Optic disc at the center of the field · non-mydriatic acquisition:
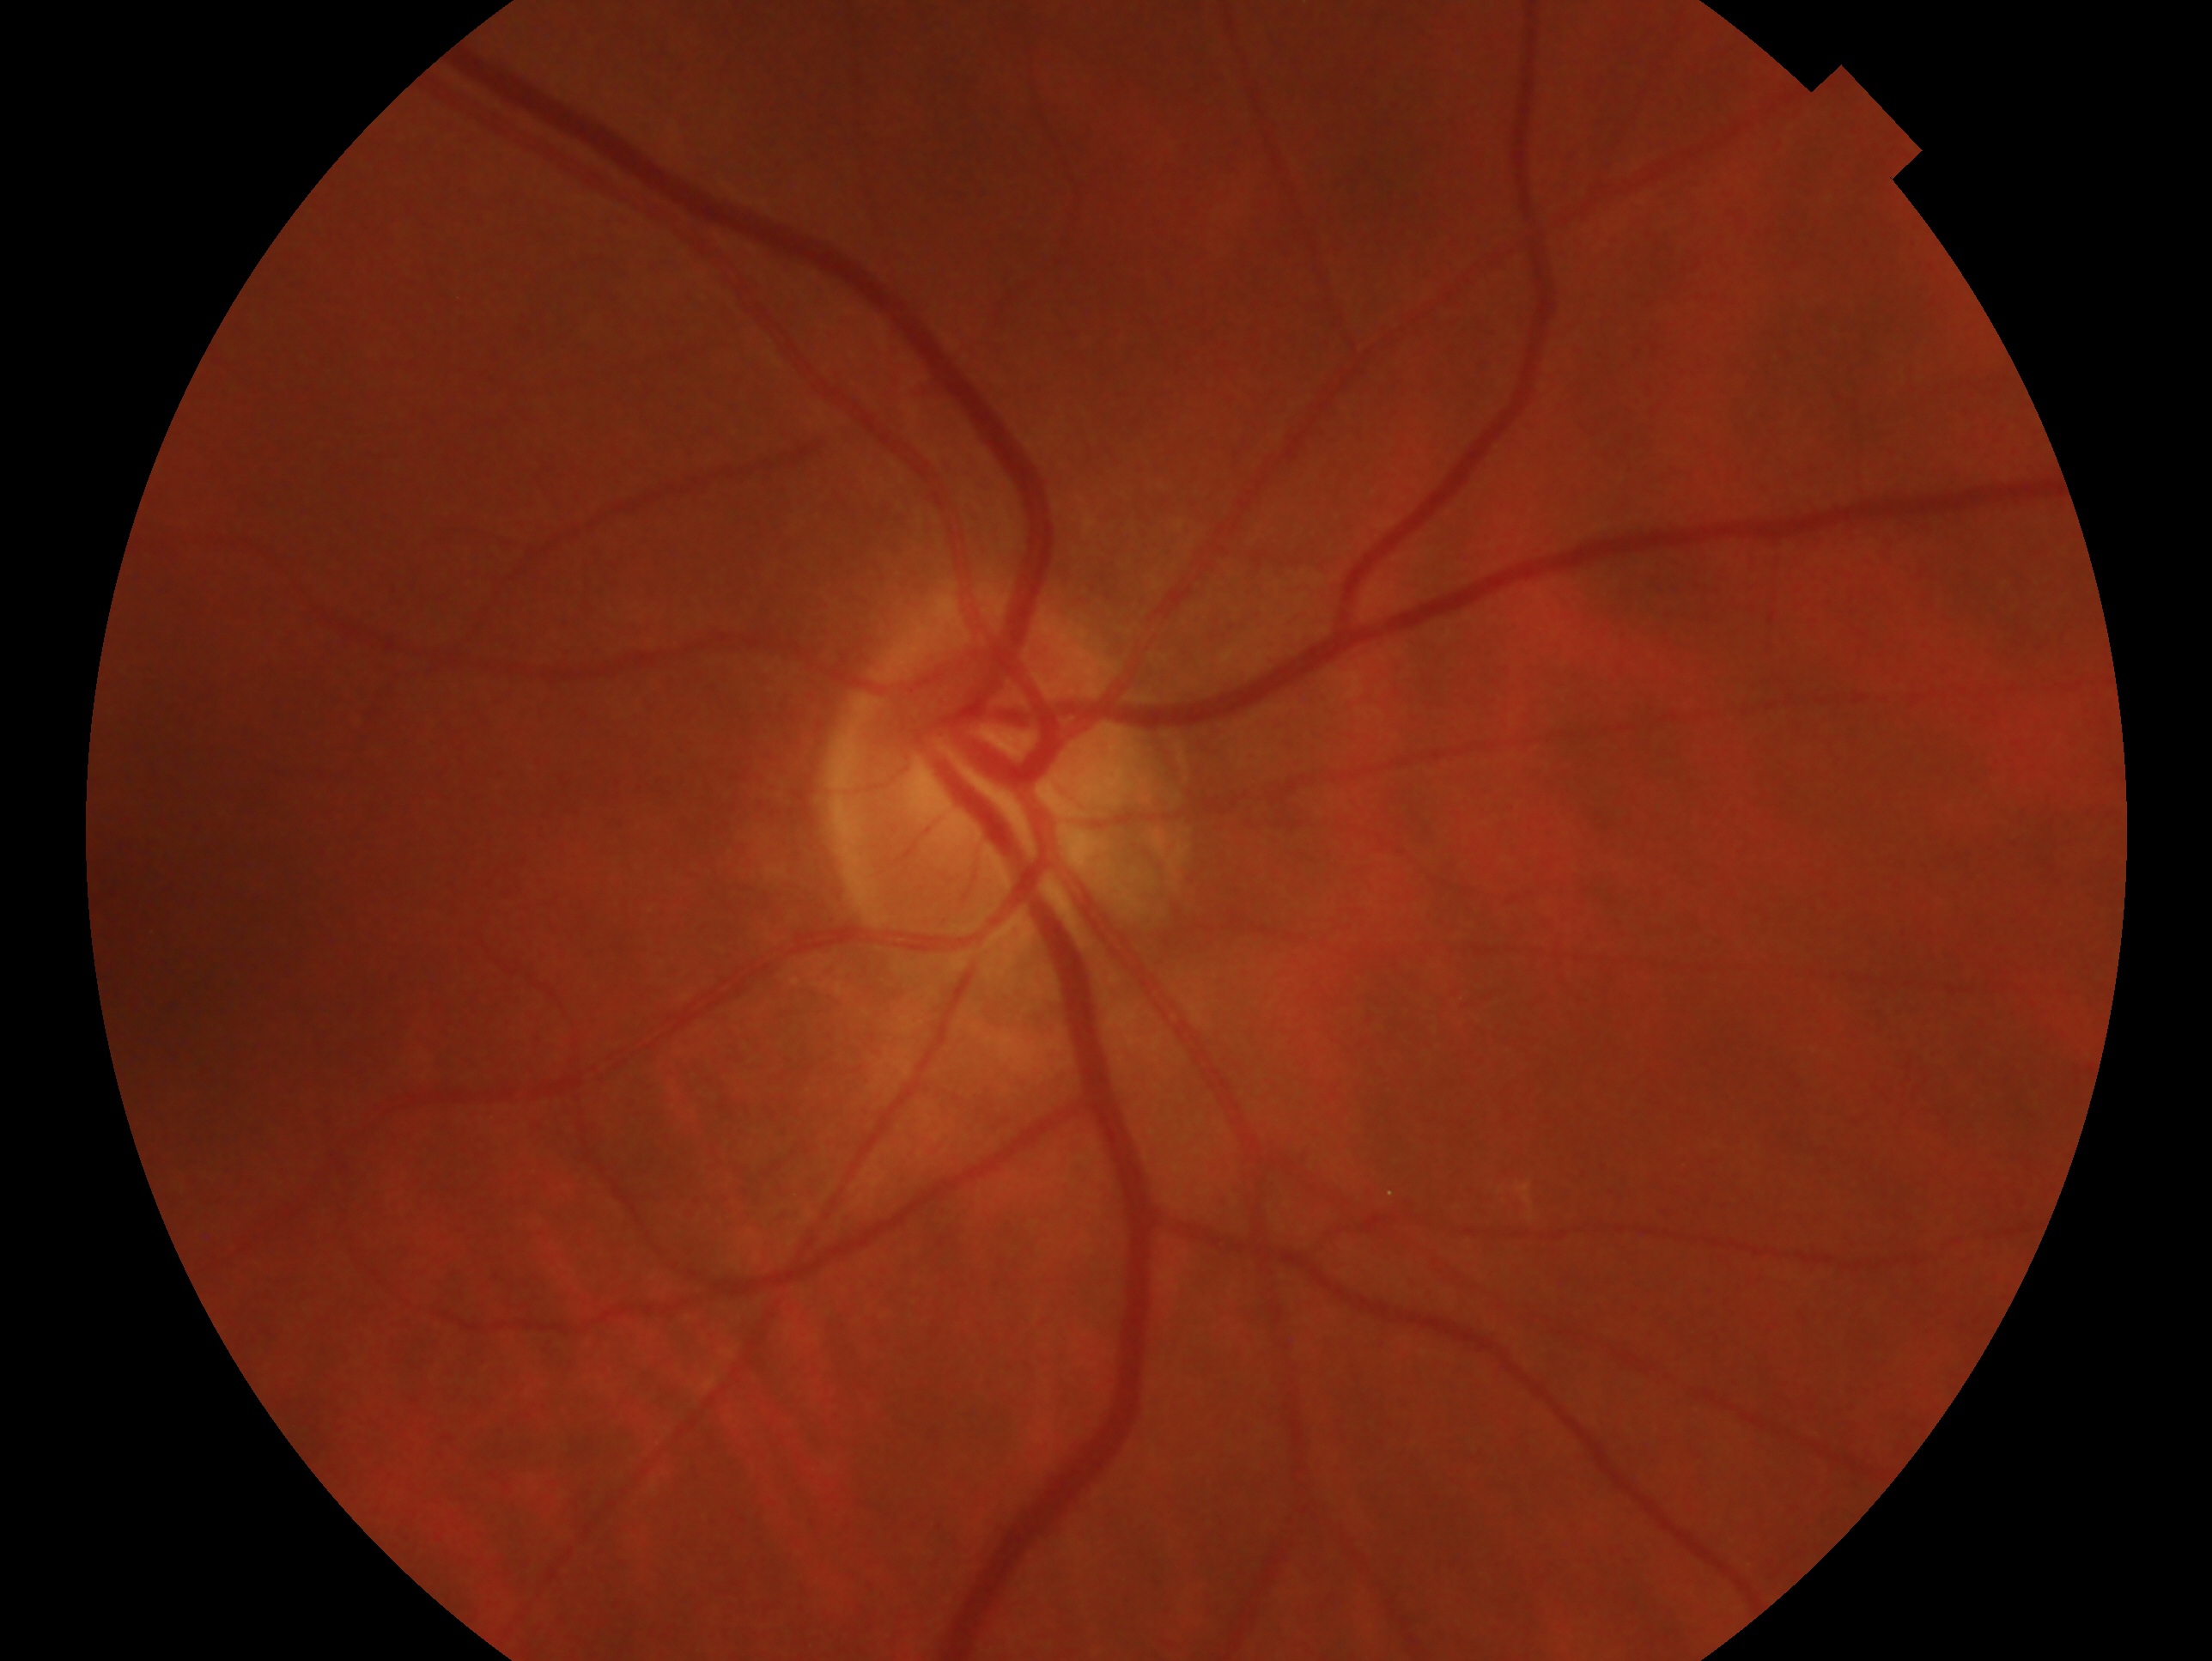

Glaucoma status: no evidence of glaucoma.
Eye: OD.